Phoenix ICON wide-field infant fundus image · 1240 x 1240 pixels
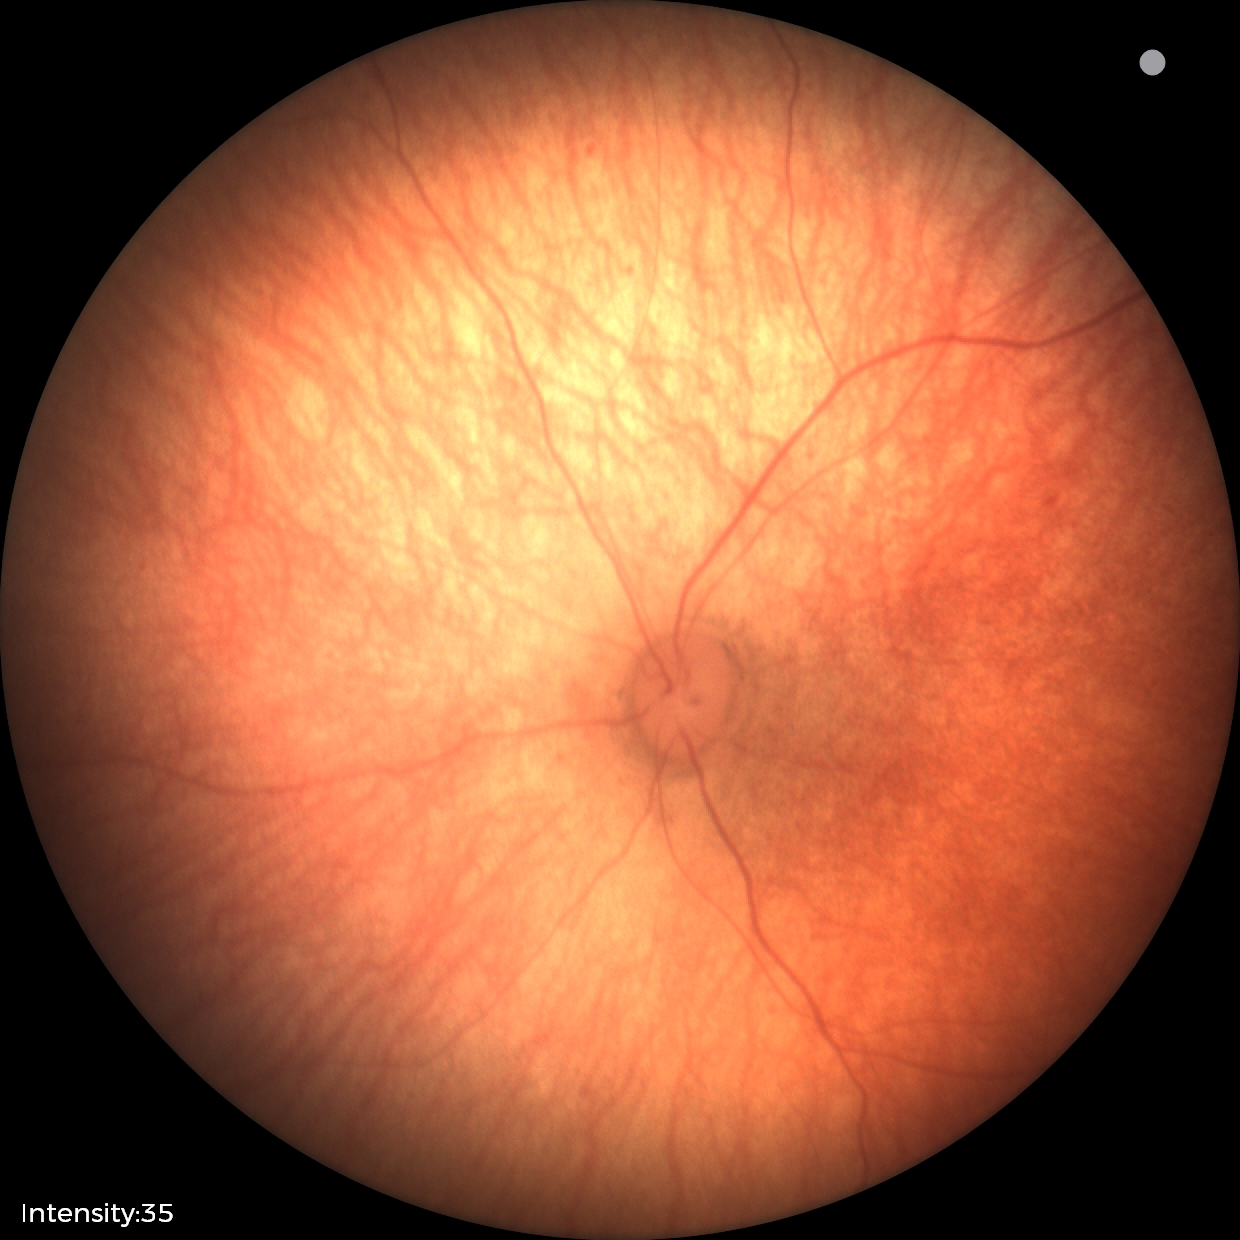
Assessment: physiological appearance with no retinal pathology.